Retinal fundus photograph — 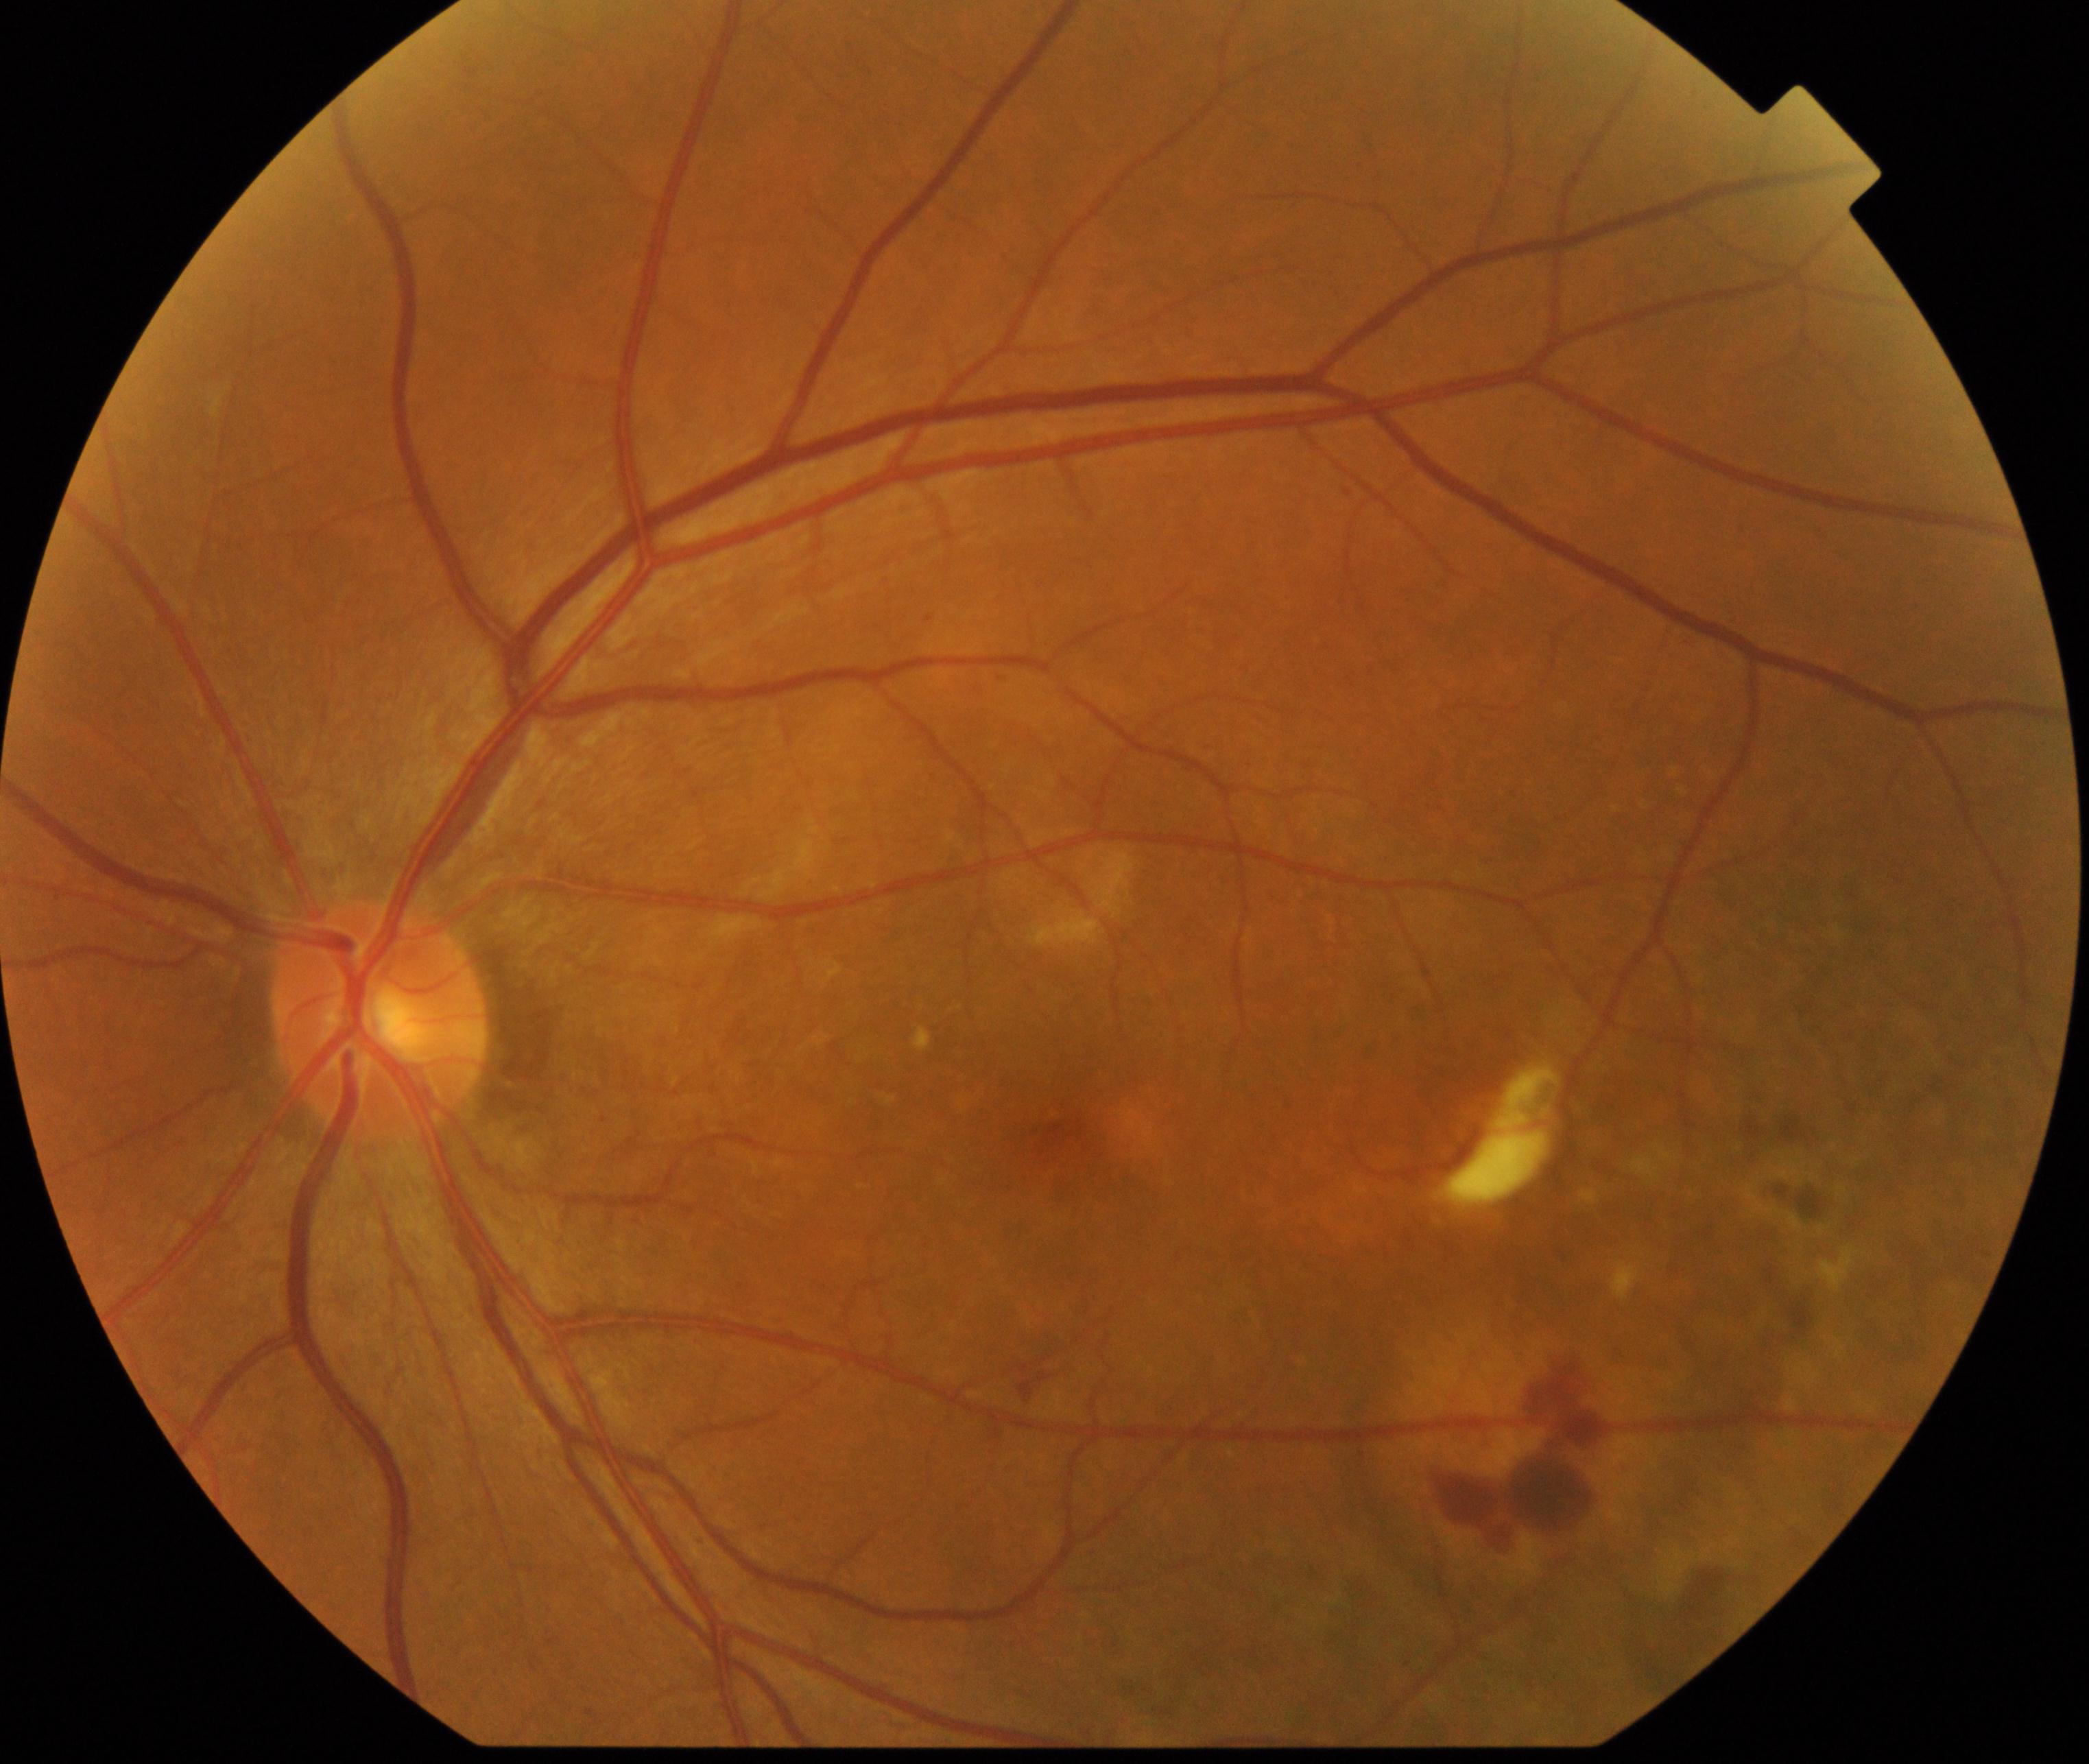 Appearance consistent with maculopathy.